50° FOV, captured on a Topcon TRC-NW8 fundus camera:
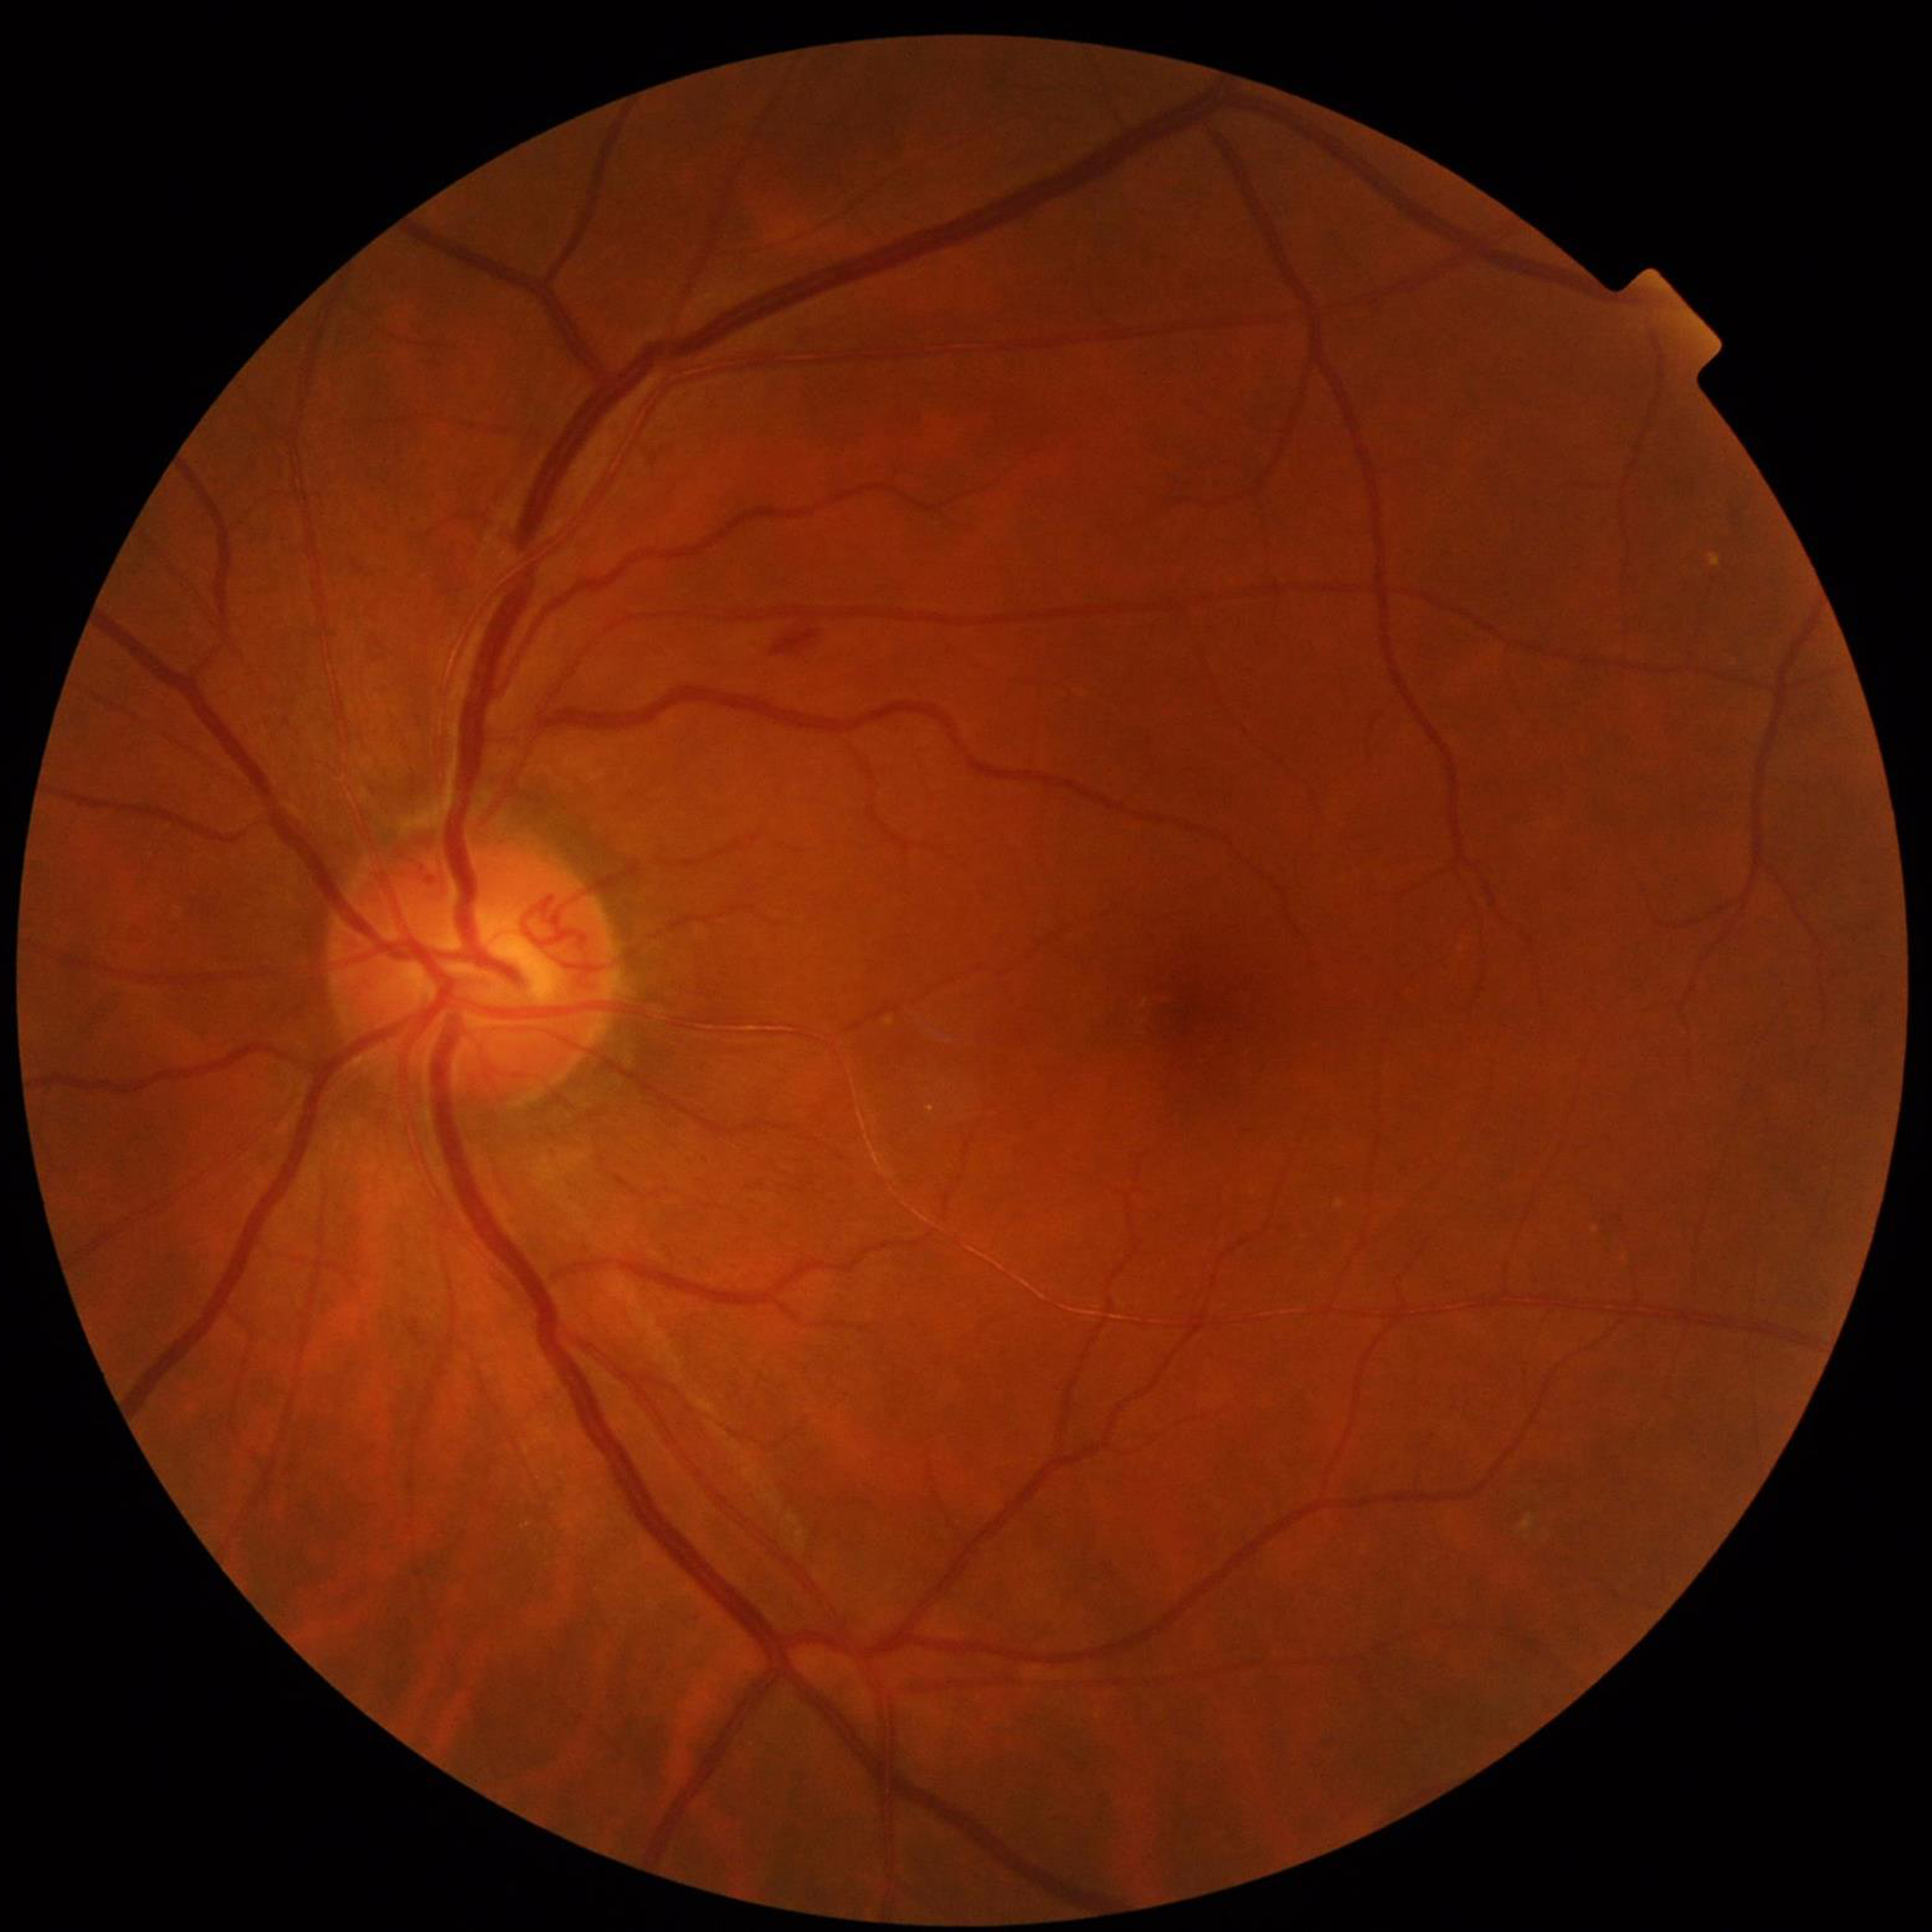
  diagnosis: diabetic retinopathy (DR)